Camera: Clarity RetCam 3 (130° FOV); infant wide-field fundus photograph: 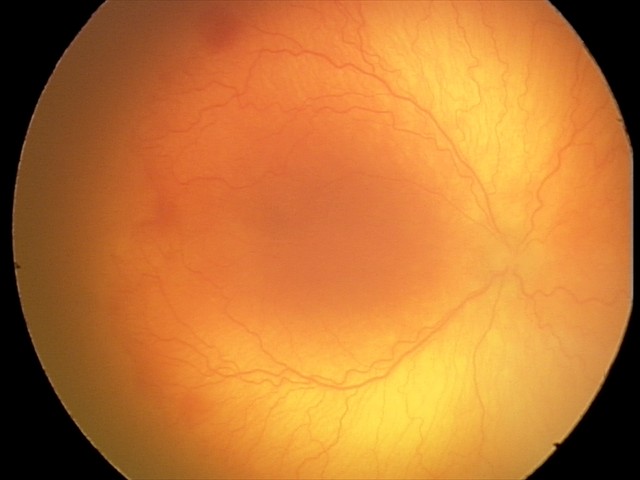 From an examination with diagnosis of aggressive retinopathy of prematurity. With plus disease.